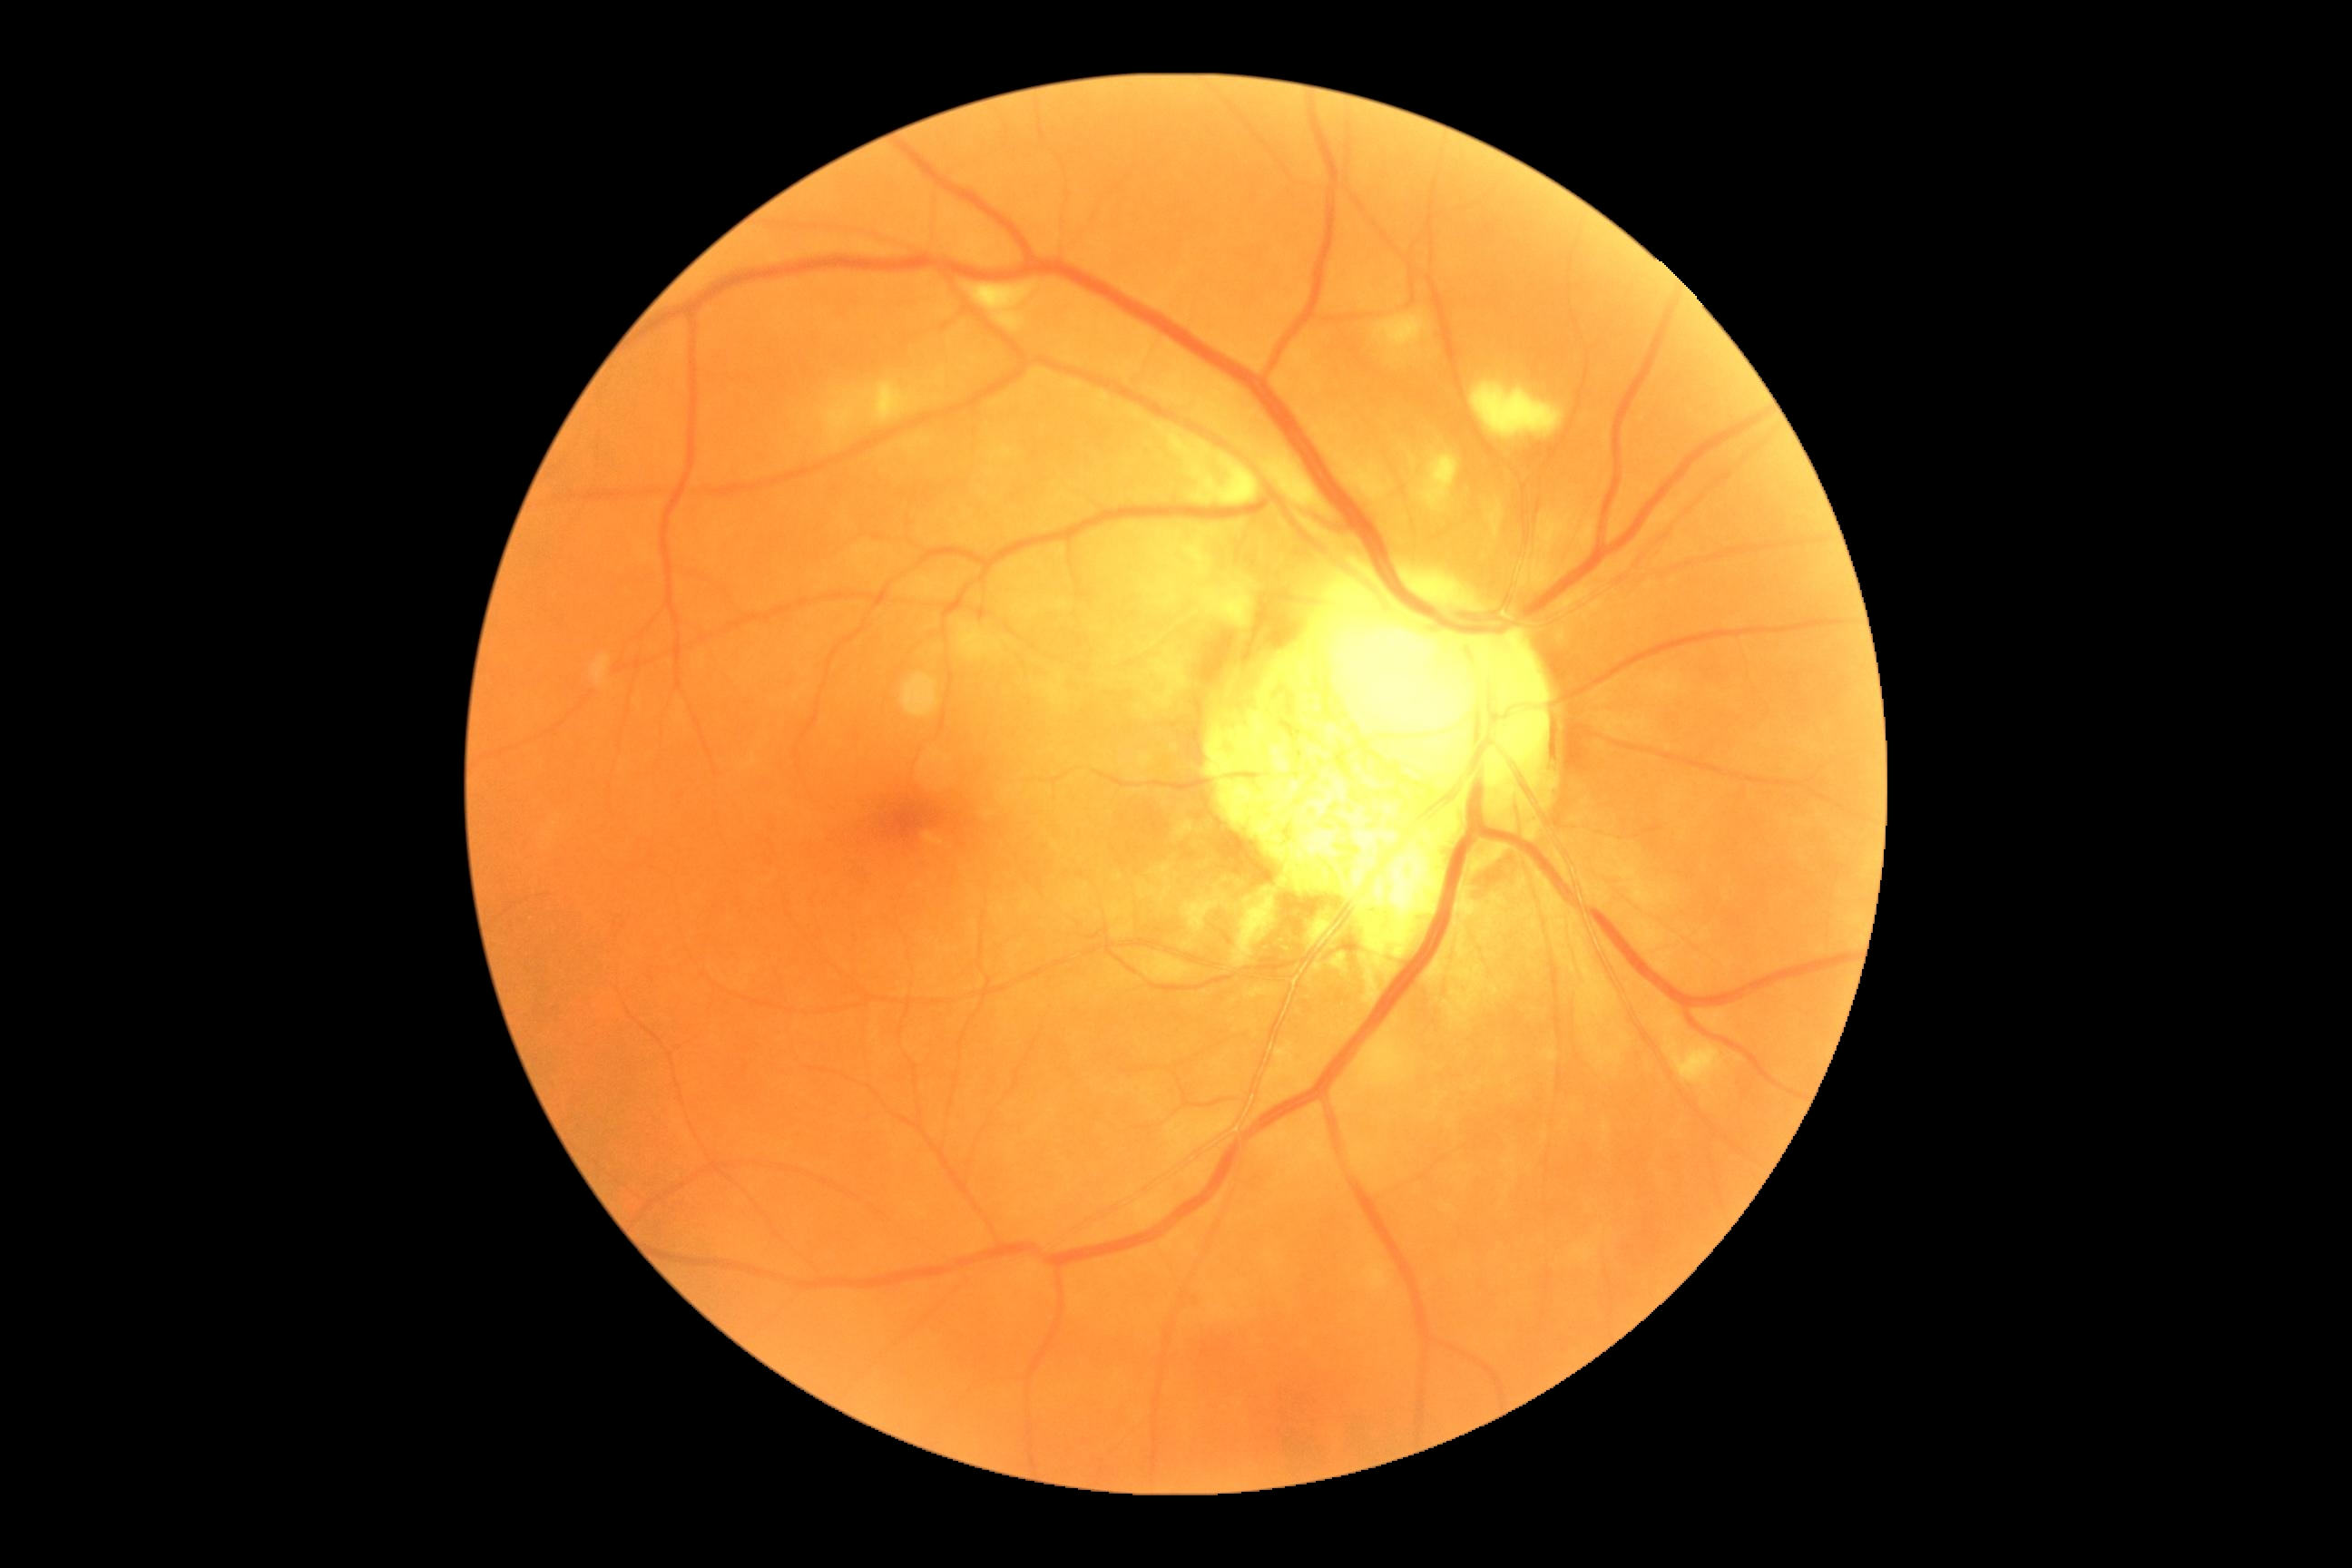
diabetic retinopathy (DR)@moderate non-proliferative diabetic retinopathy (grade 2).